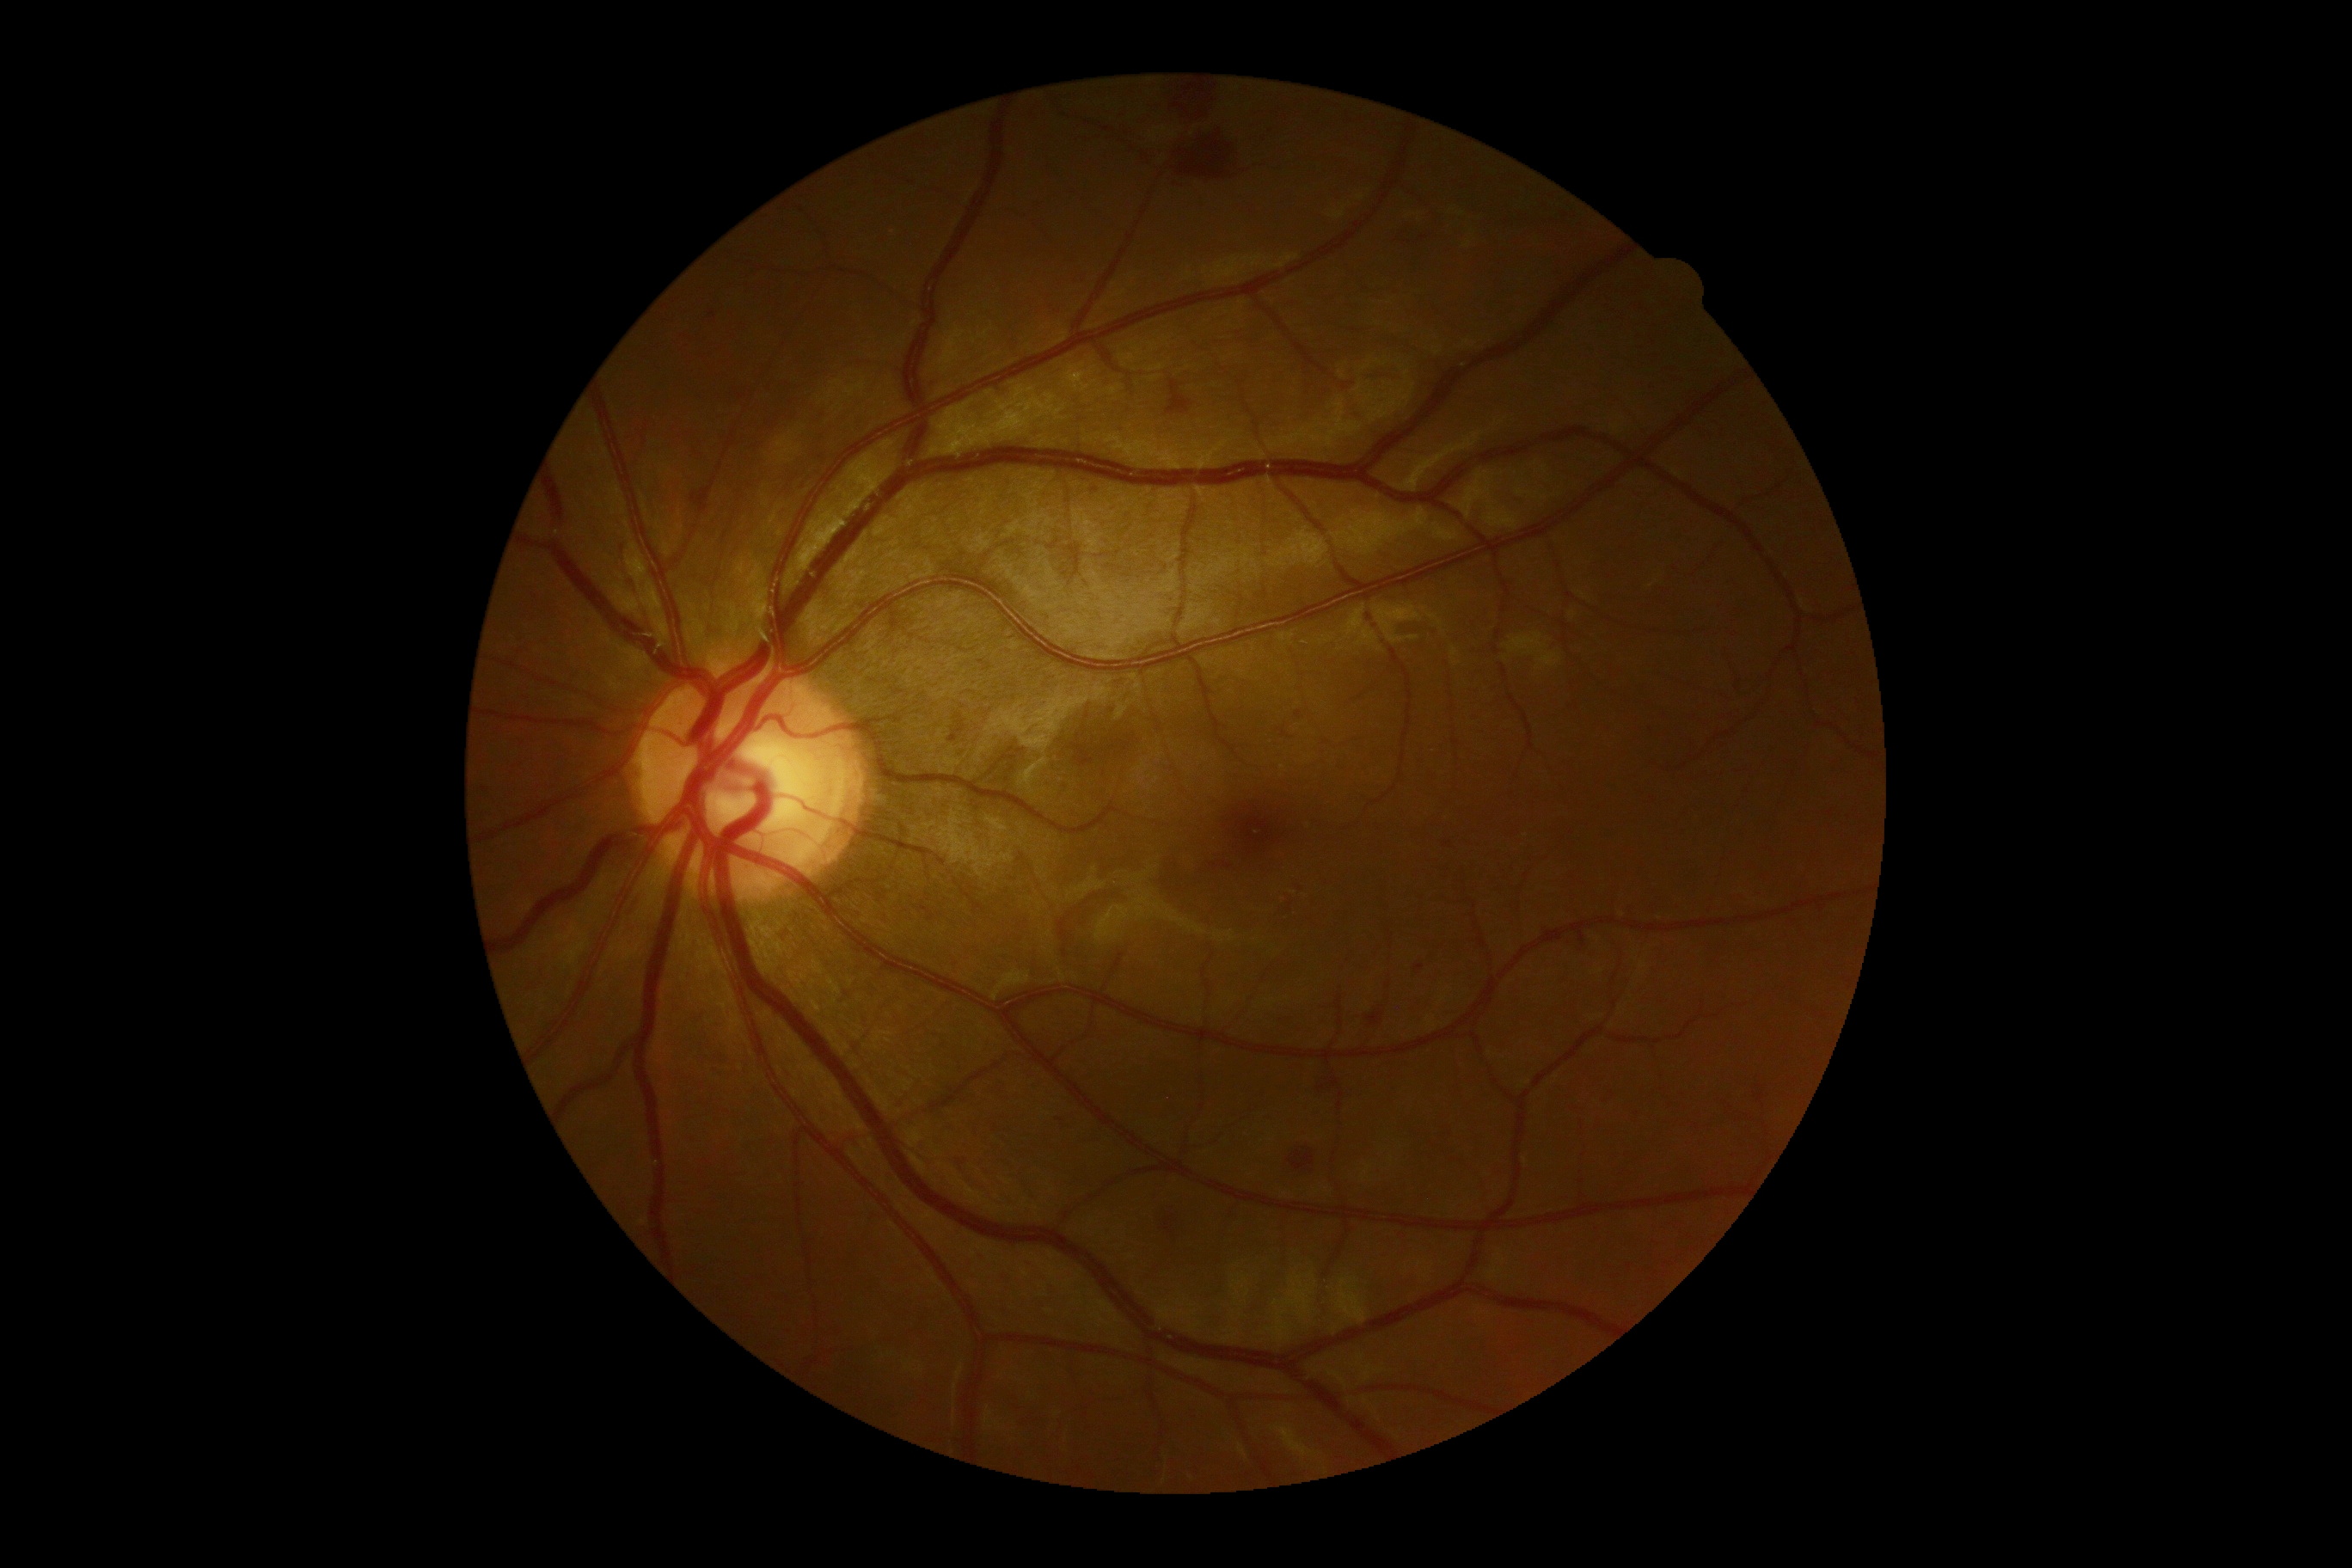   dr_grade: moderate non-proliferative diabetic retinopathy (grade 2)